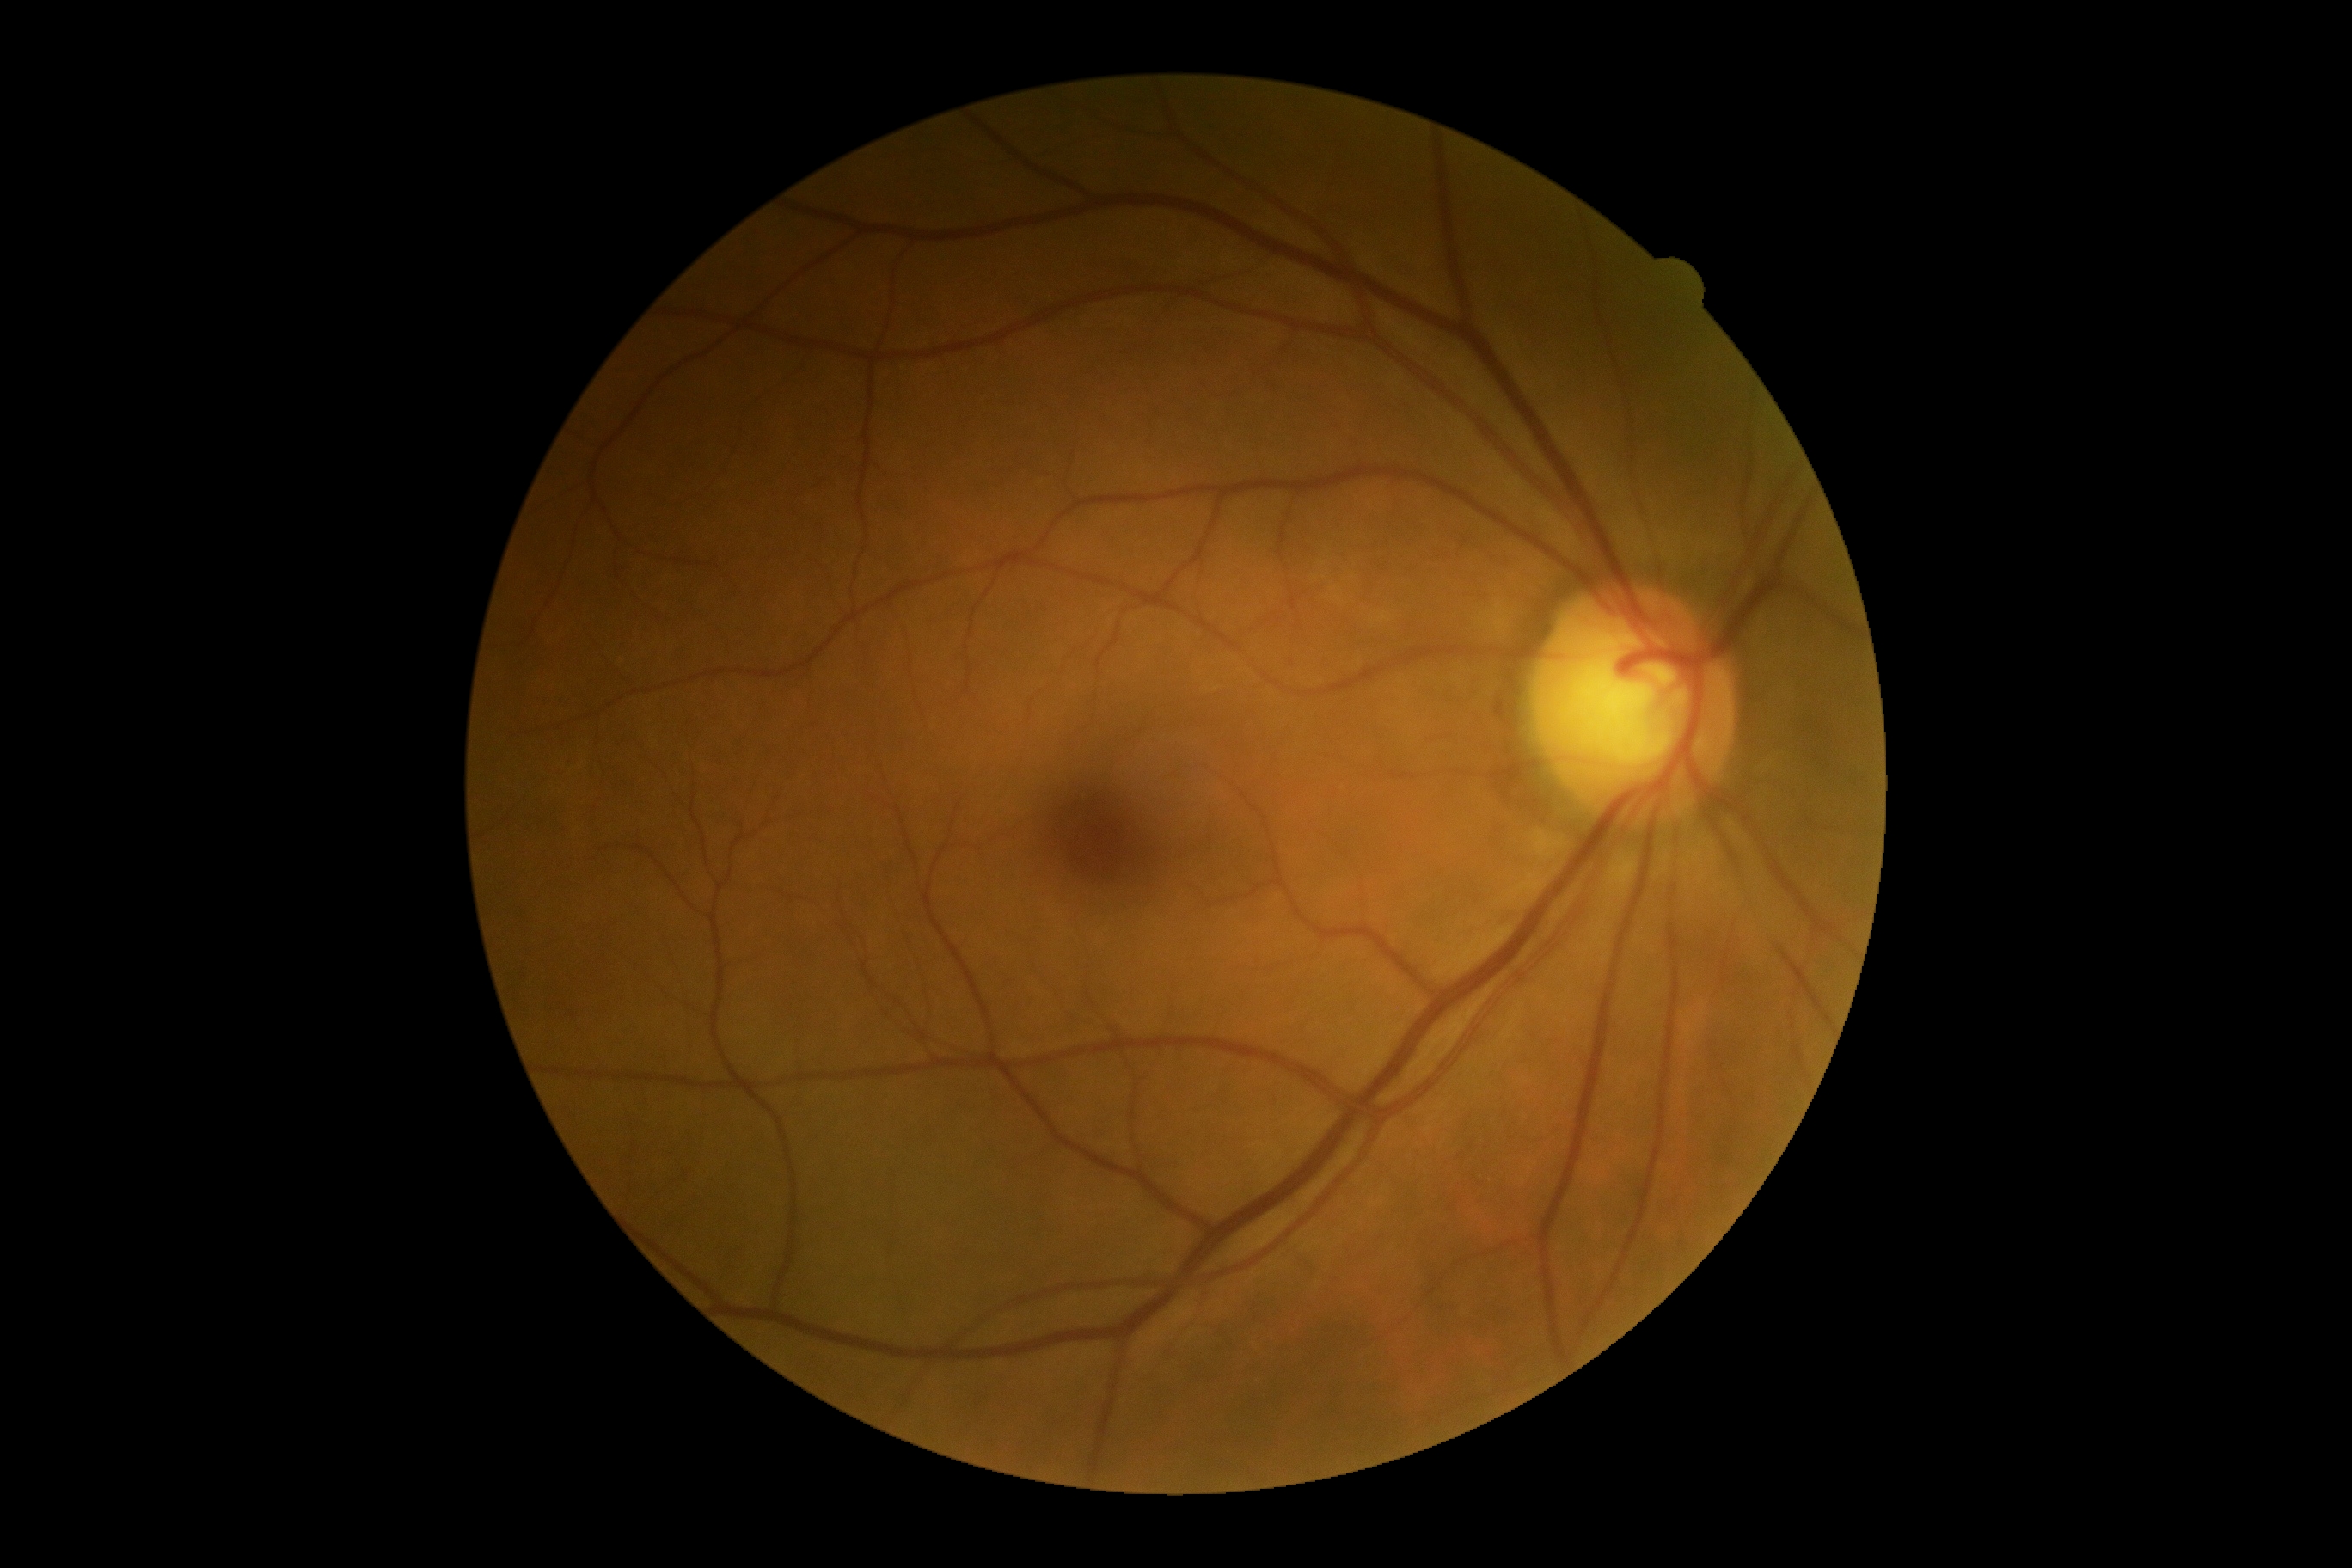
Diabetic retinopathy (DR): 0/4.